Color fundus photograph
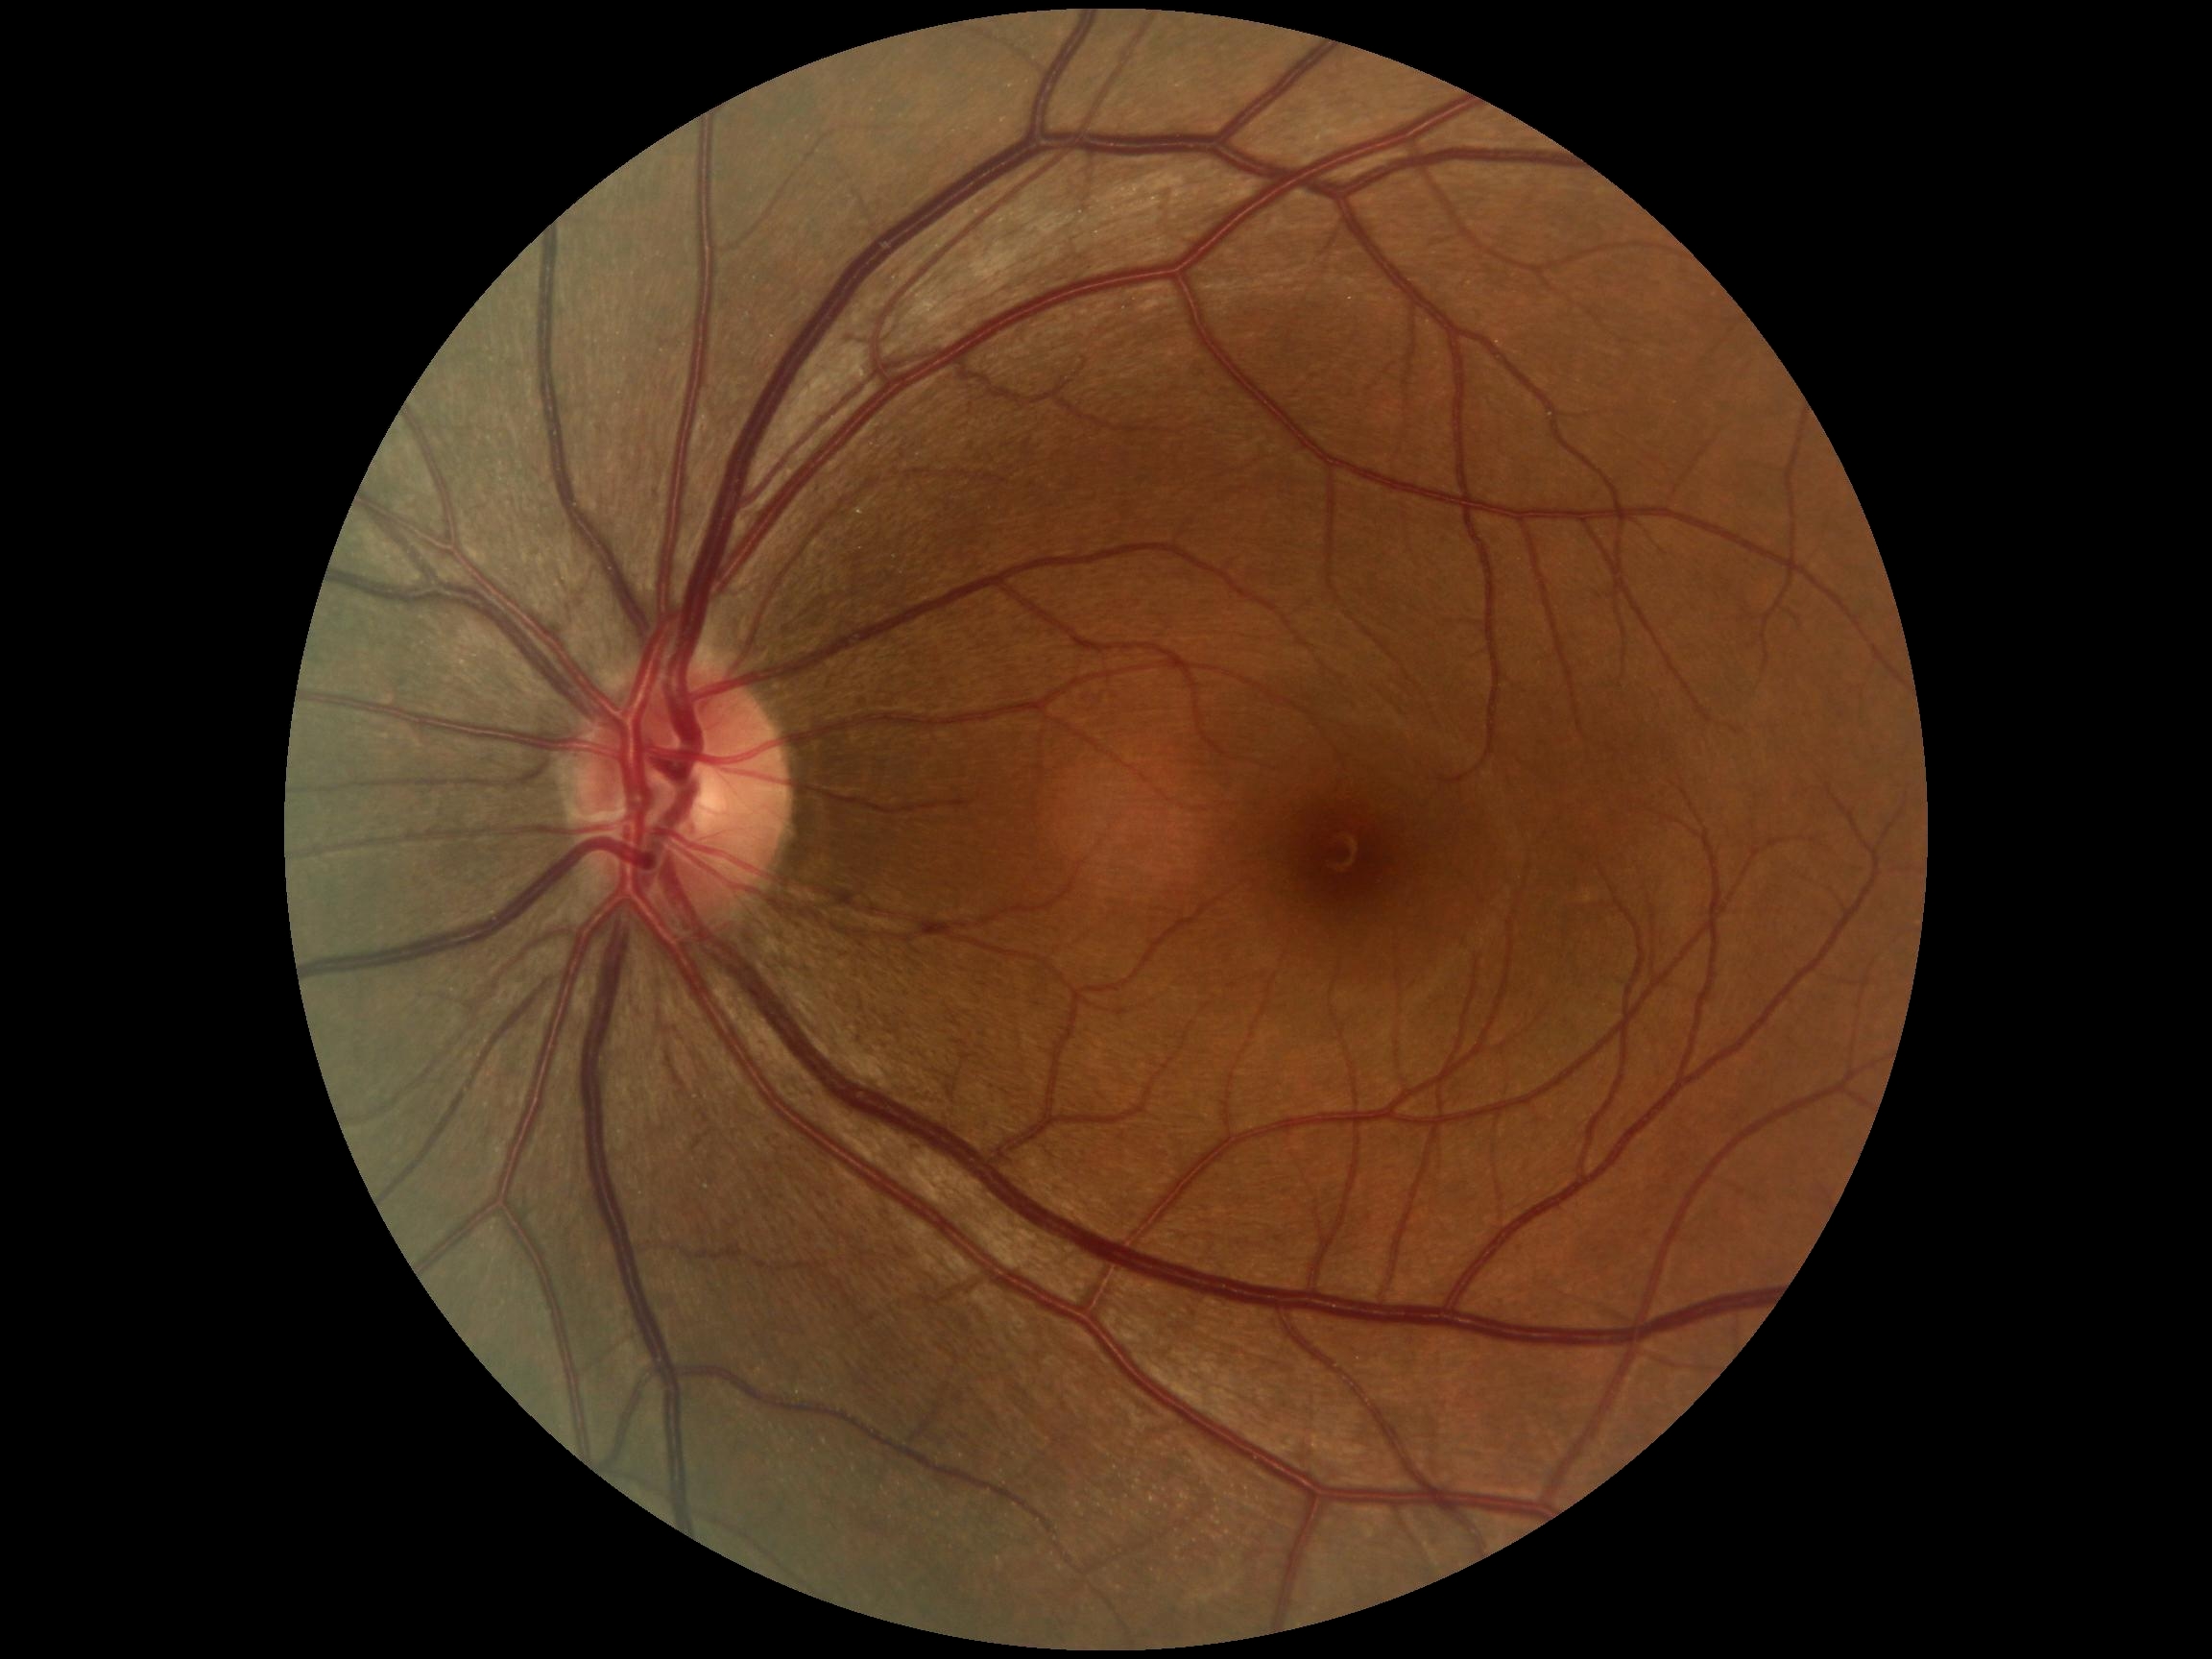
Findings:
– DR grade: 0